Acquired with a NIDEK AFC-230 · 848x848px · modified Davis grading — 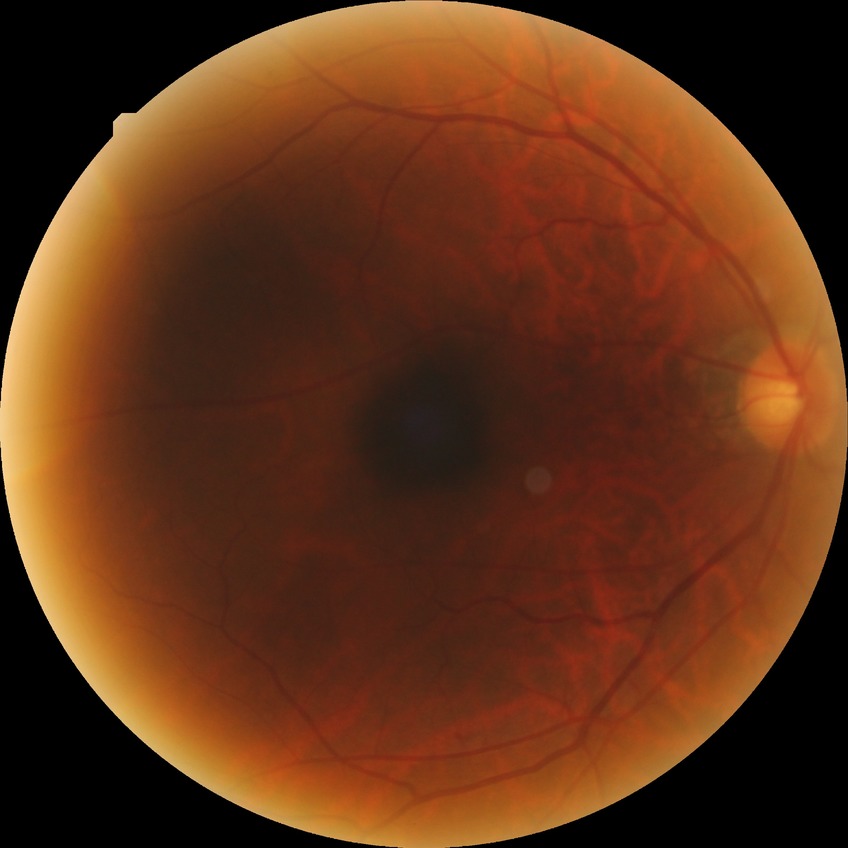 Diabetic retinopathy severity is simple diabetic retinopathy.